2352x1568px, 45-degree field of view, fundus photo: 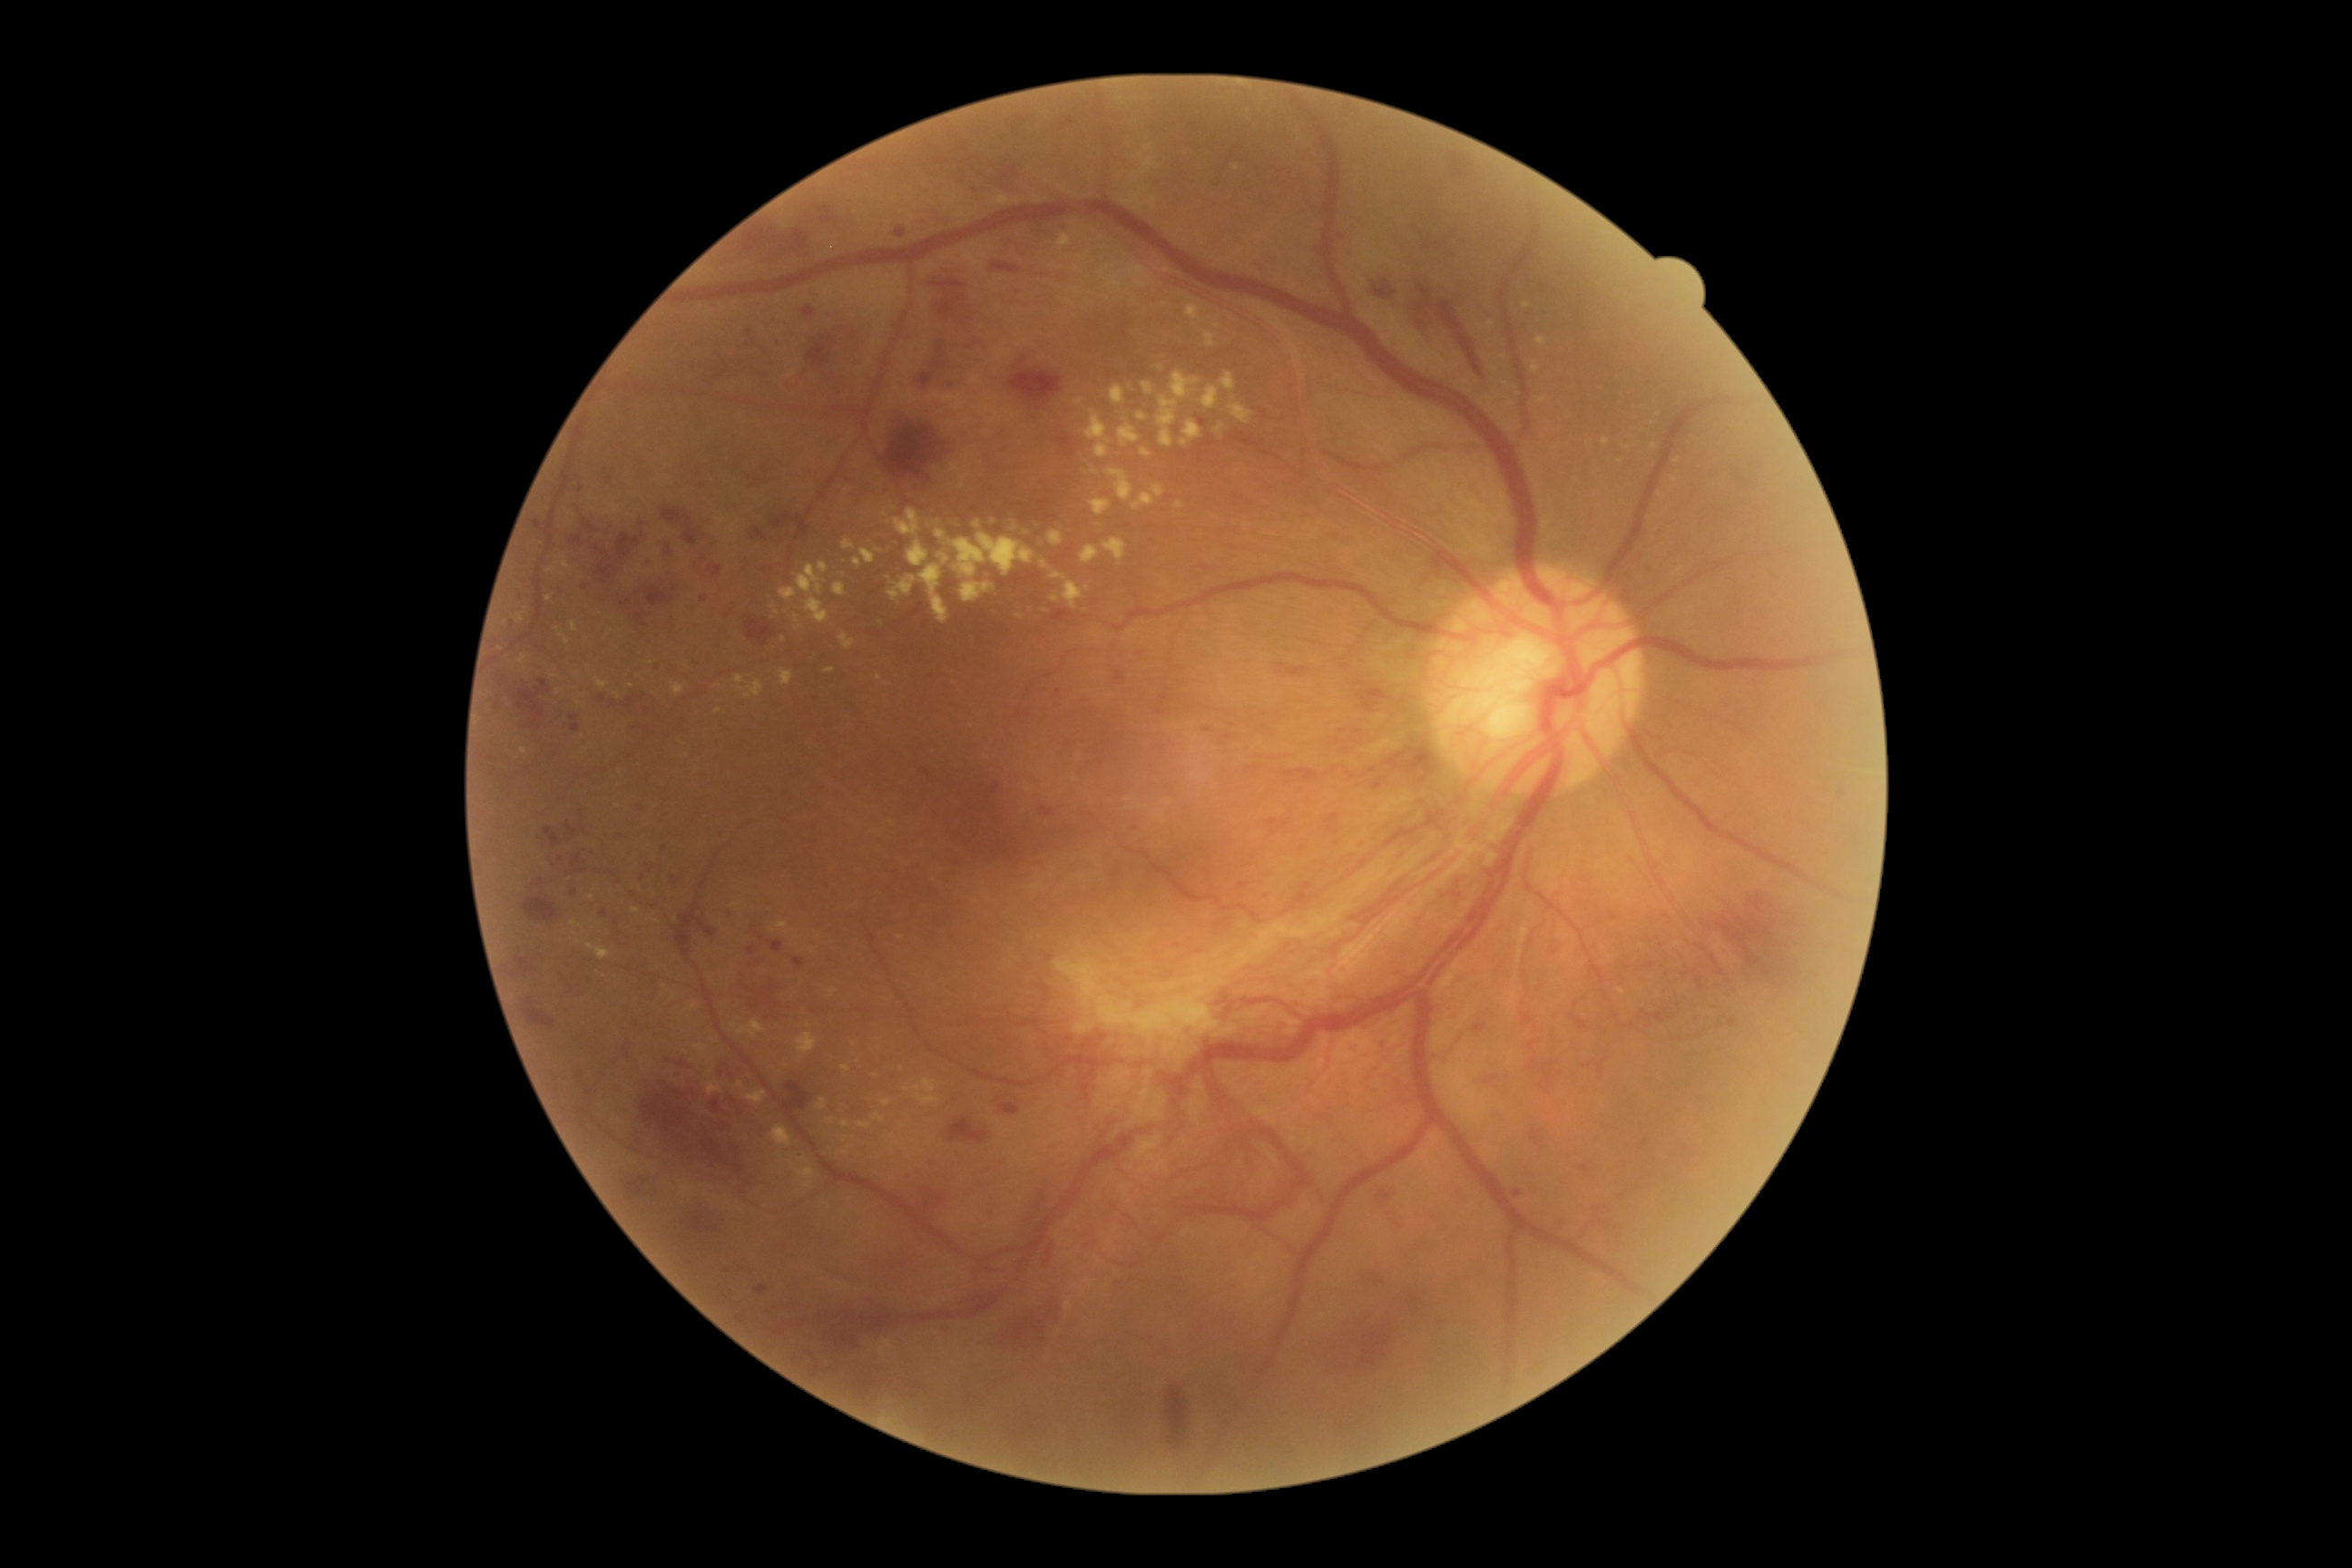
{"partial": true, "dr_grade": 4, "dr_grade_name": "PDR", "lesions": {"ex": [[745, 1090, 769, 1104], [1141, 449, 1152, 458], [1220, 373, 1235, 391], [694, 1044, 709, 1054], [888, 576, 917, 602], [948, 533, 1037, 578], [596, 678, 609, 691], [1119, 424, 1141, 446], [1175, 502, 1184, 509], [729, 524, 736, 534], [562, 634, 571, 645]], "ex_small_centers": [[880, 678], [891, 823], [993, 522], [1621, 991], [1676, 480], [618, 806], [888, 684], [524, 751]], "he": [[565, 825, 576, 834], [1400, 847, 1407, 859], [634, 1077, 774, 1181], [1266, 819, 1277, 827], [594, 534, 640, 587], [1204, 729, 1215, 734], [625, 1179, 647, 1200], [1168, 1387, 1188, 1449], [516, 957, 533, 974], [1378, 1191, 1391, 1202], [1003, 1104, 1019, 1117], [1008, 239, 1030, 253], [594, 694, 607, 707], [785, 322, 850, 387], [1367, 1273, 1384, 1288], [718, 1059, 745, 1086], [1749, 892, 1778, 925], [1453, 157, 1471, 179]], "he_small_centers": [[1358, 731]], "se": null, "ma": [[571, 888, 580, 897], [896, 228, 906, 239], [542, 827, 551, 834], [1513, 1190, 1522, 1197], [714, 830, 721, 838], [612, 830, 623, 841], [770, 941, 783, 952], [747, 329, 752, 337], [504, 622, 513, 627]], "ma_small_centers": [[1141, 654], [704, 559], [1599, 946], [1645, 1144], [705, 600], [627, 1050], [1419, 1301]]}}